NIDEK AFC-230.
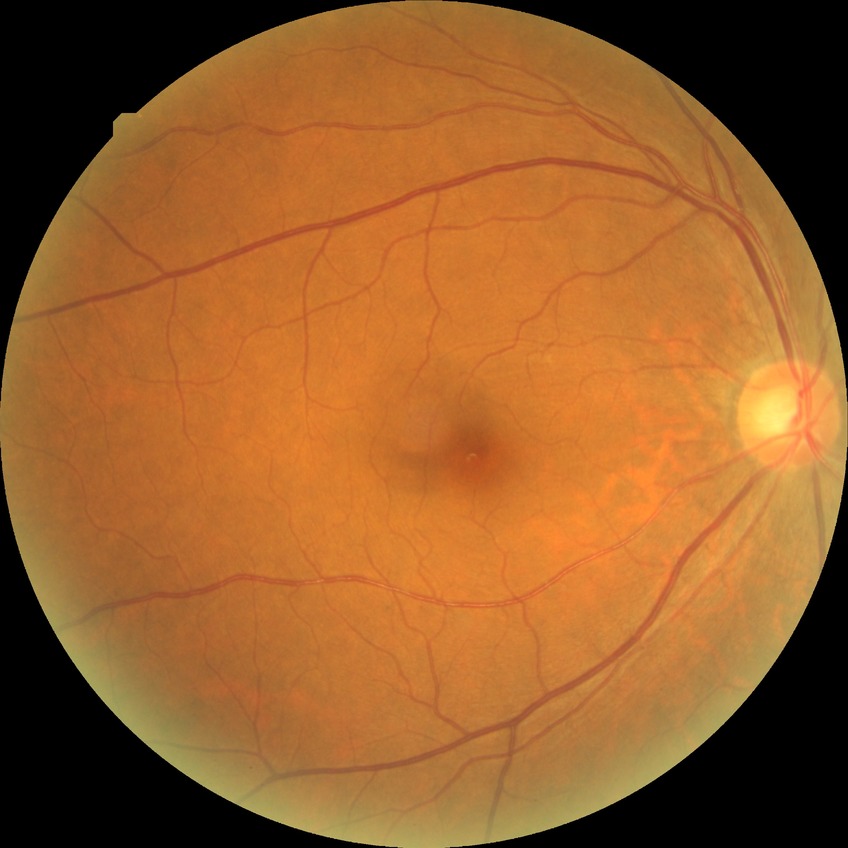

Retinopathy grade: simple diabetic retinopathy.